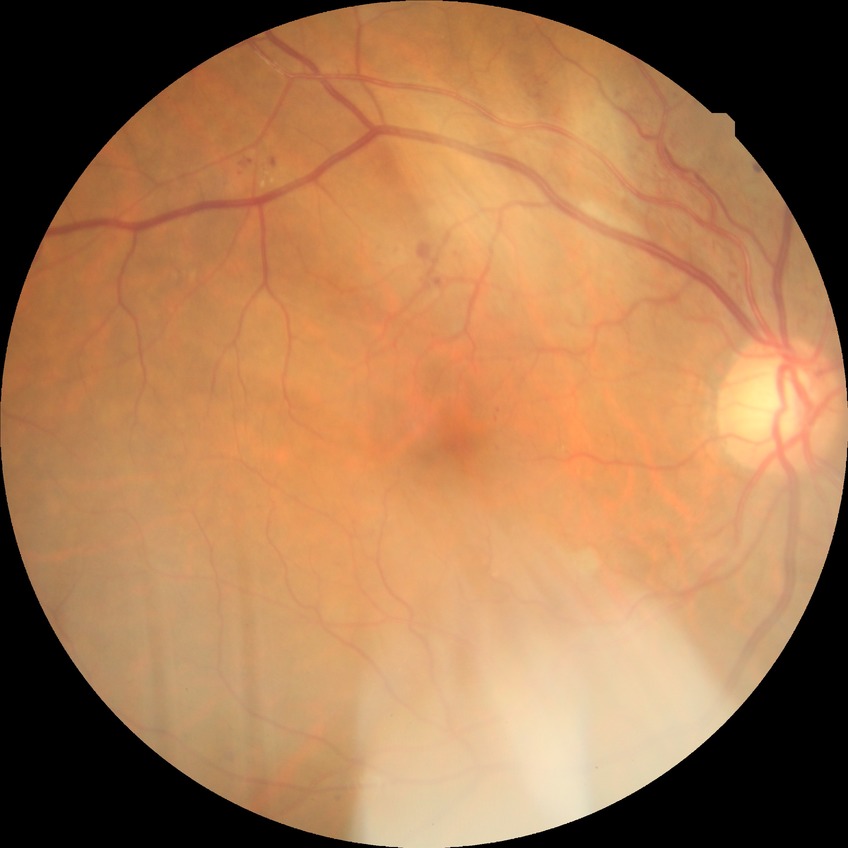 Davis grading: pre-proliferative diabetic retinopathy.